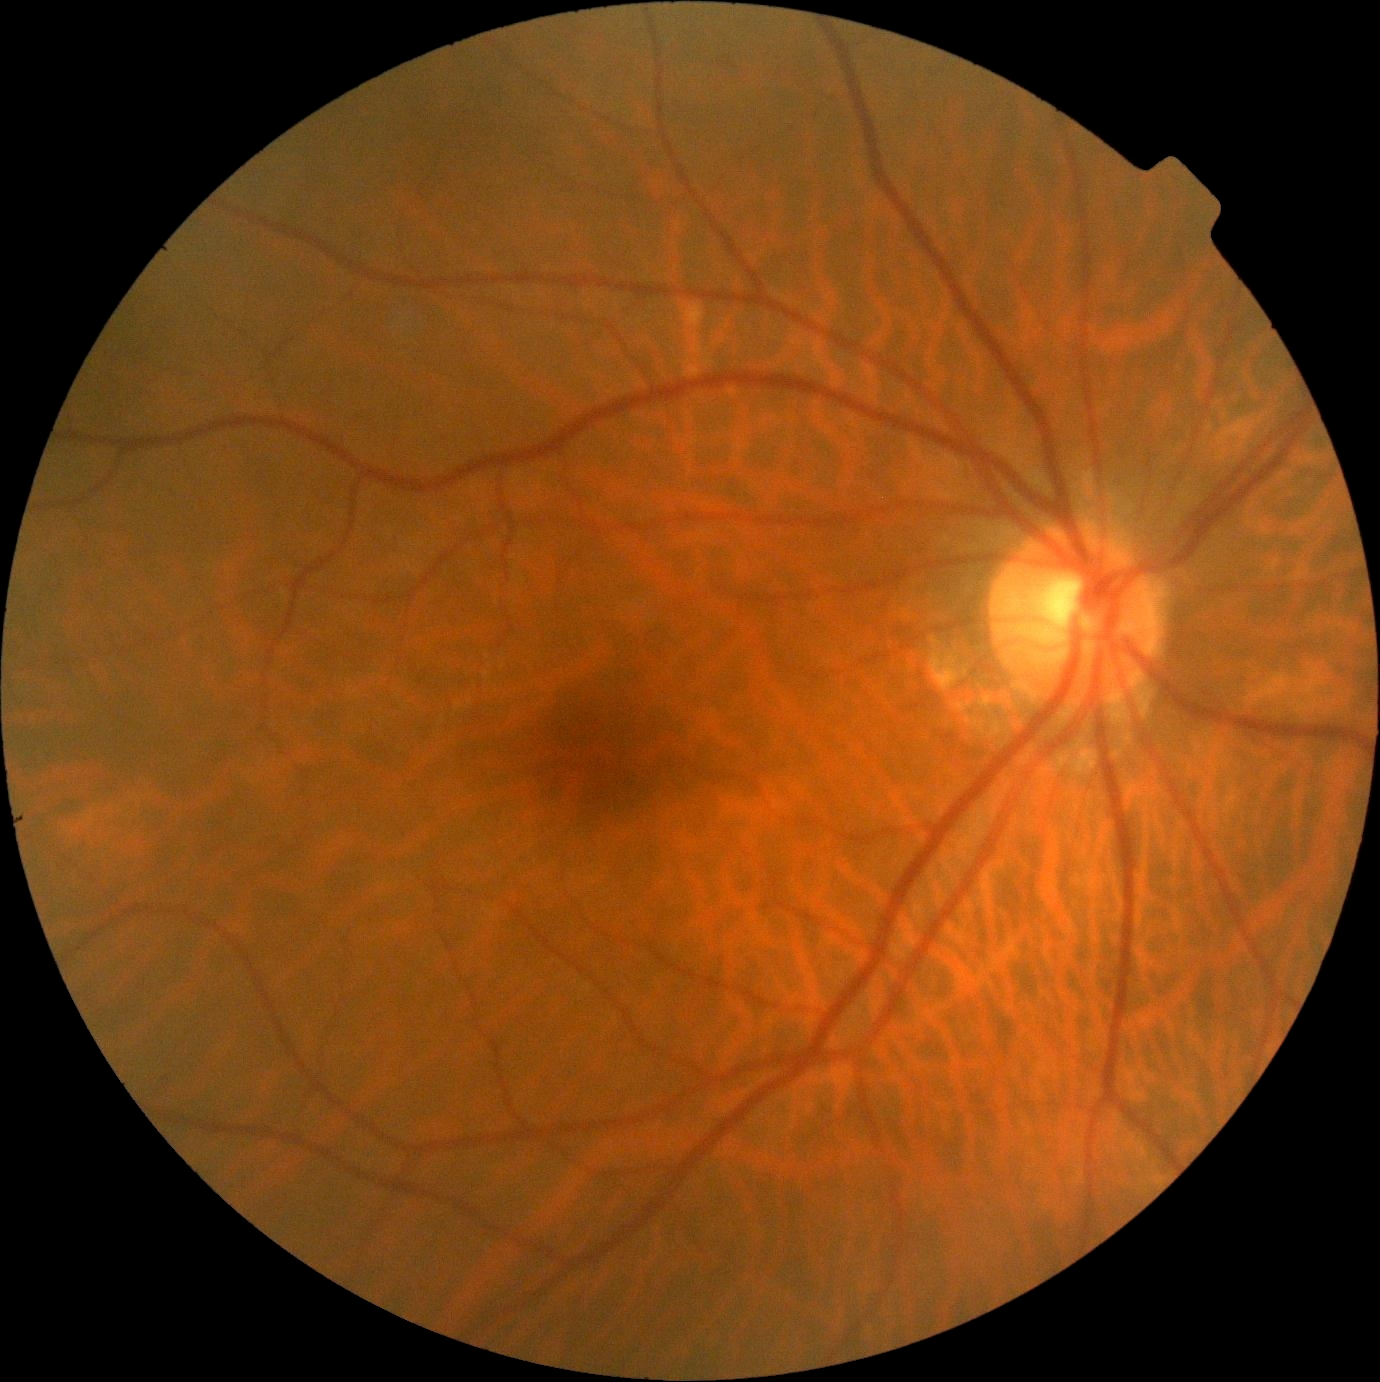 DR severity = no apparent diabetic retinopathy (grade 0), DR impression = negative for DR.